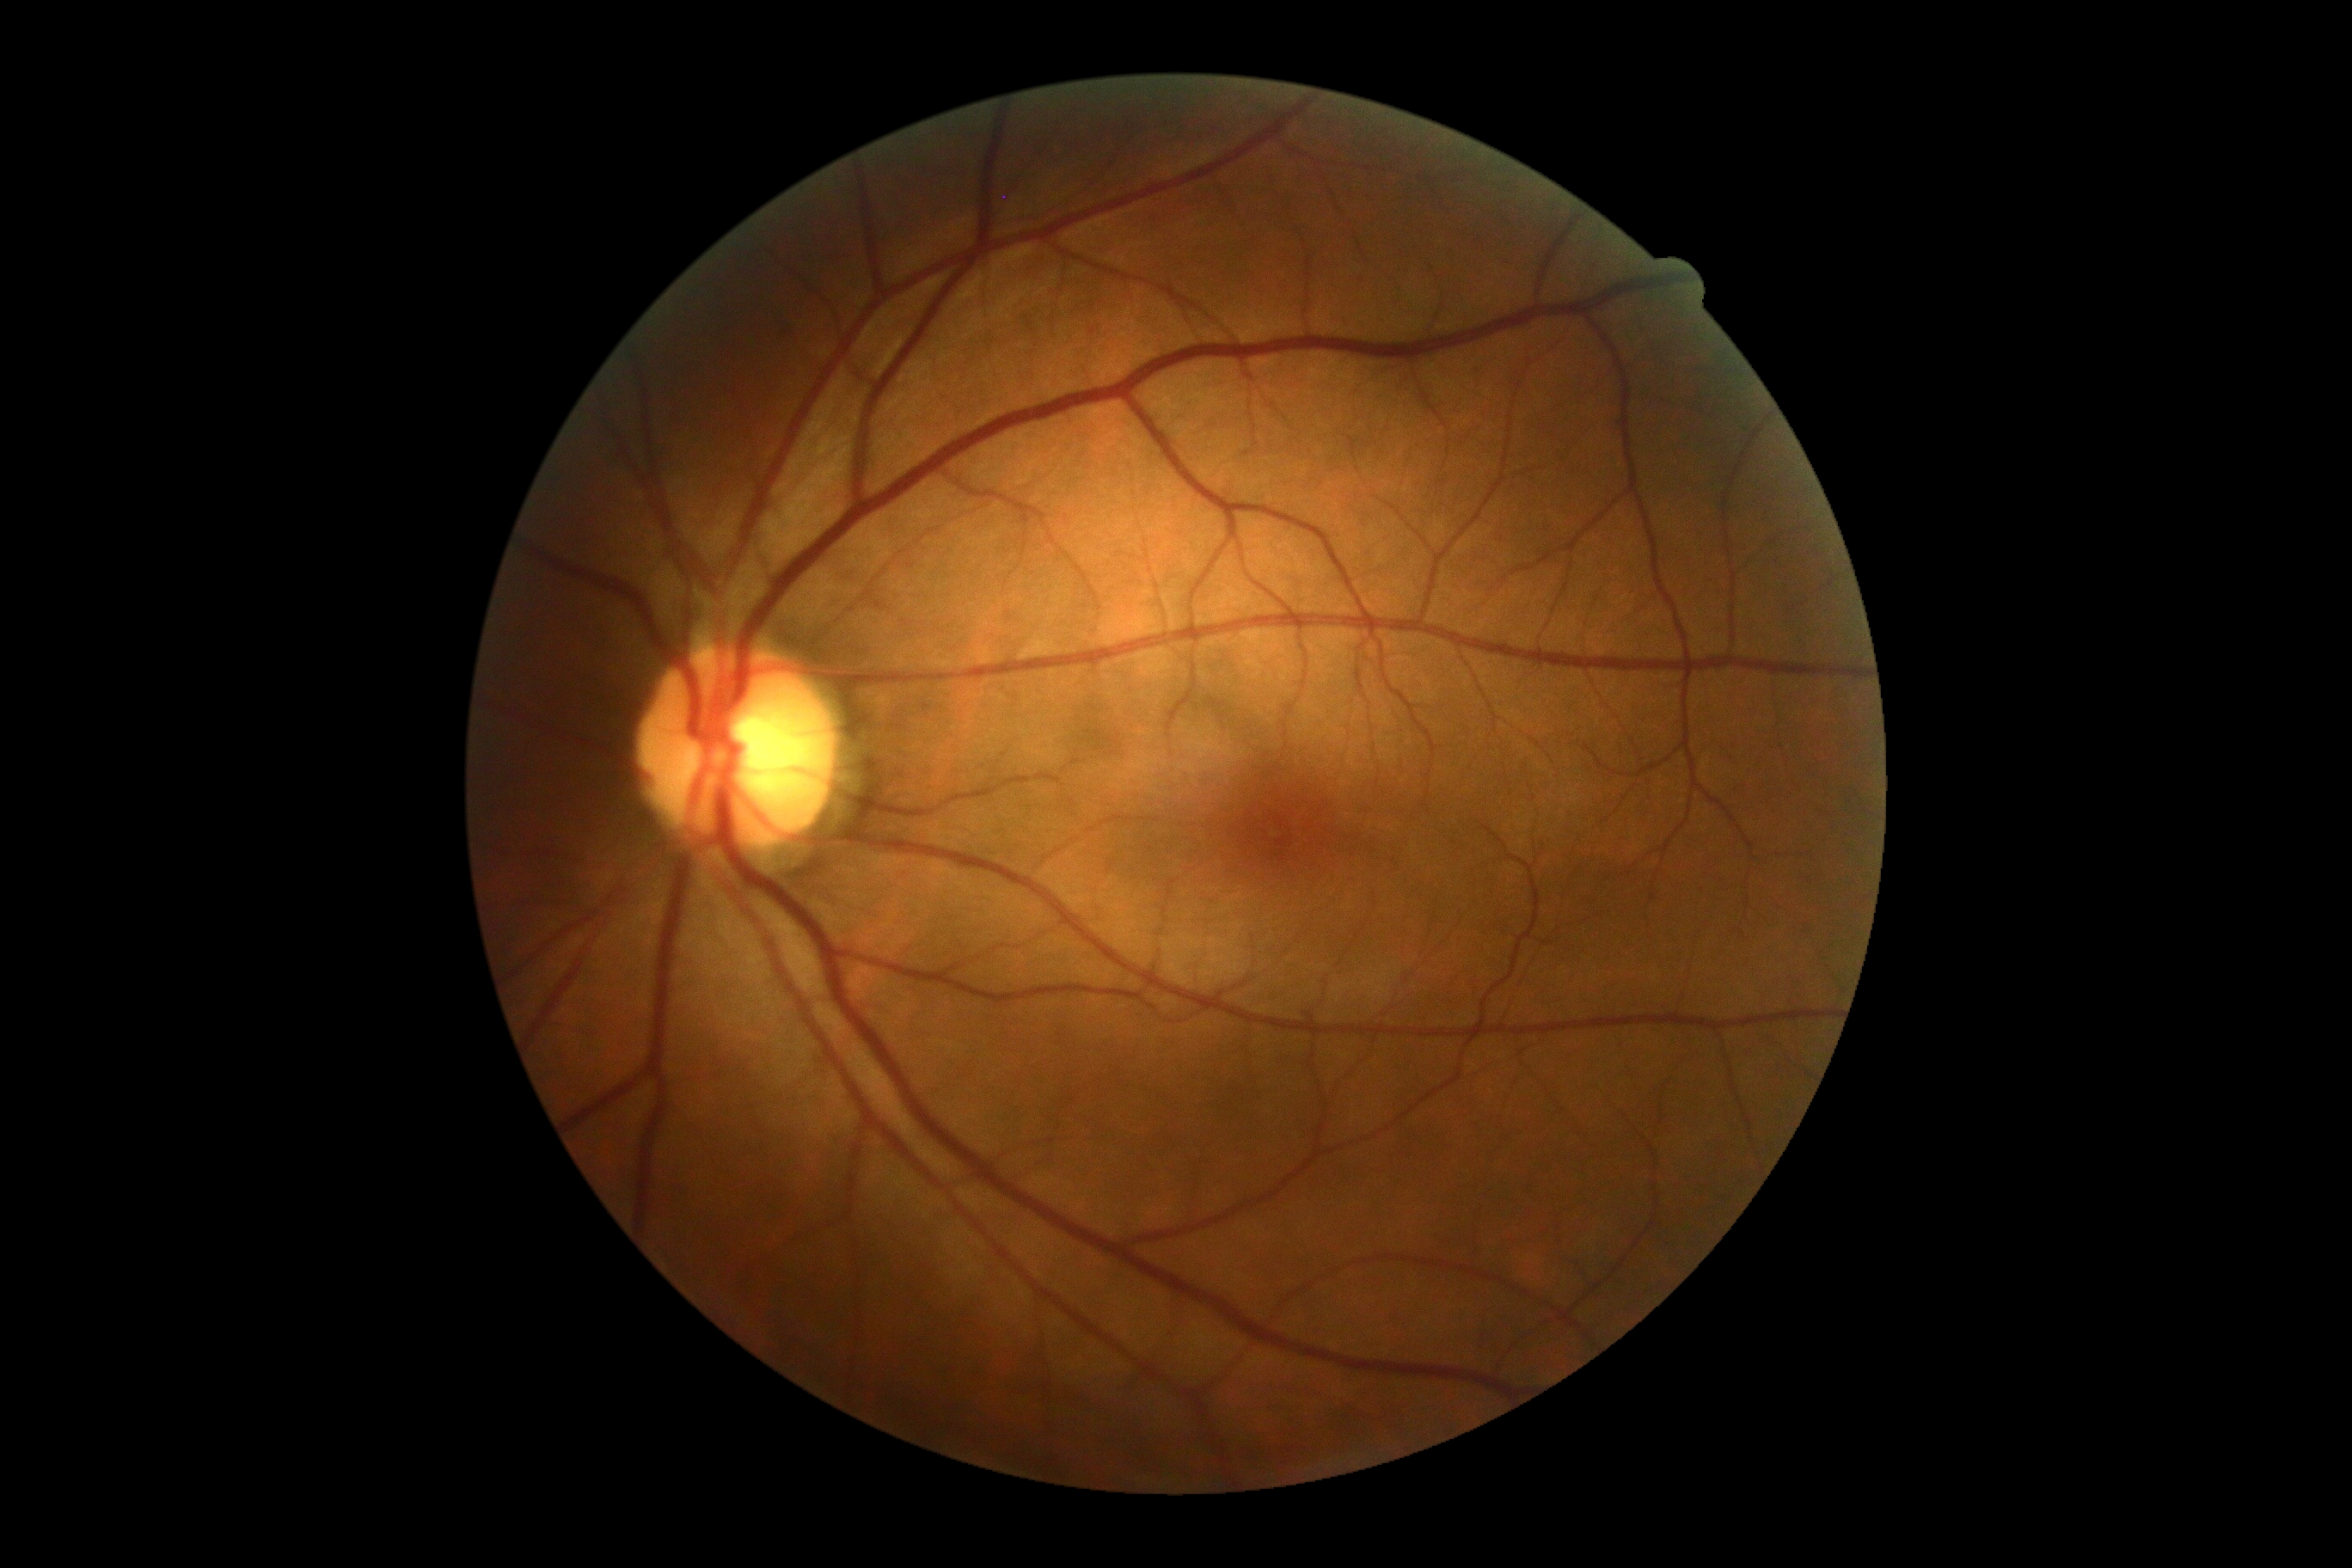
DR severity is no apparent retinopathy (grade 0).